45° field of view, color fundus photograph, image size 2352x1568: 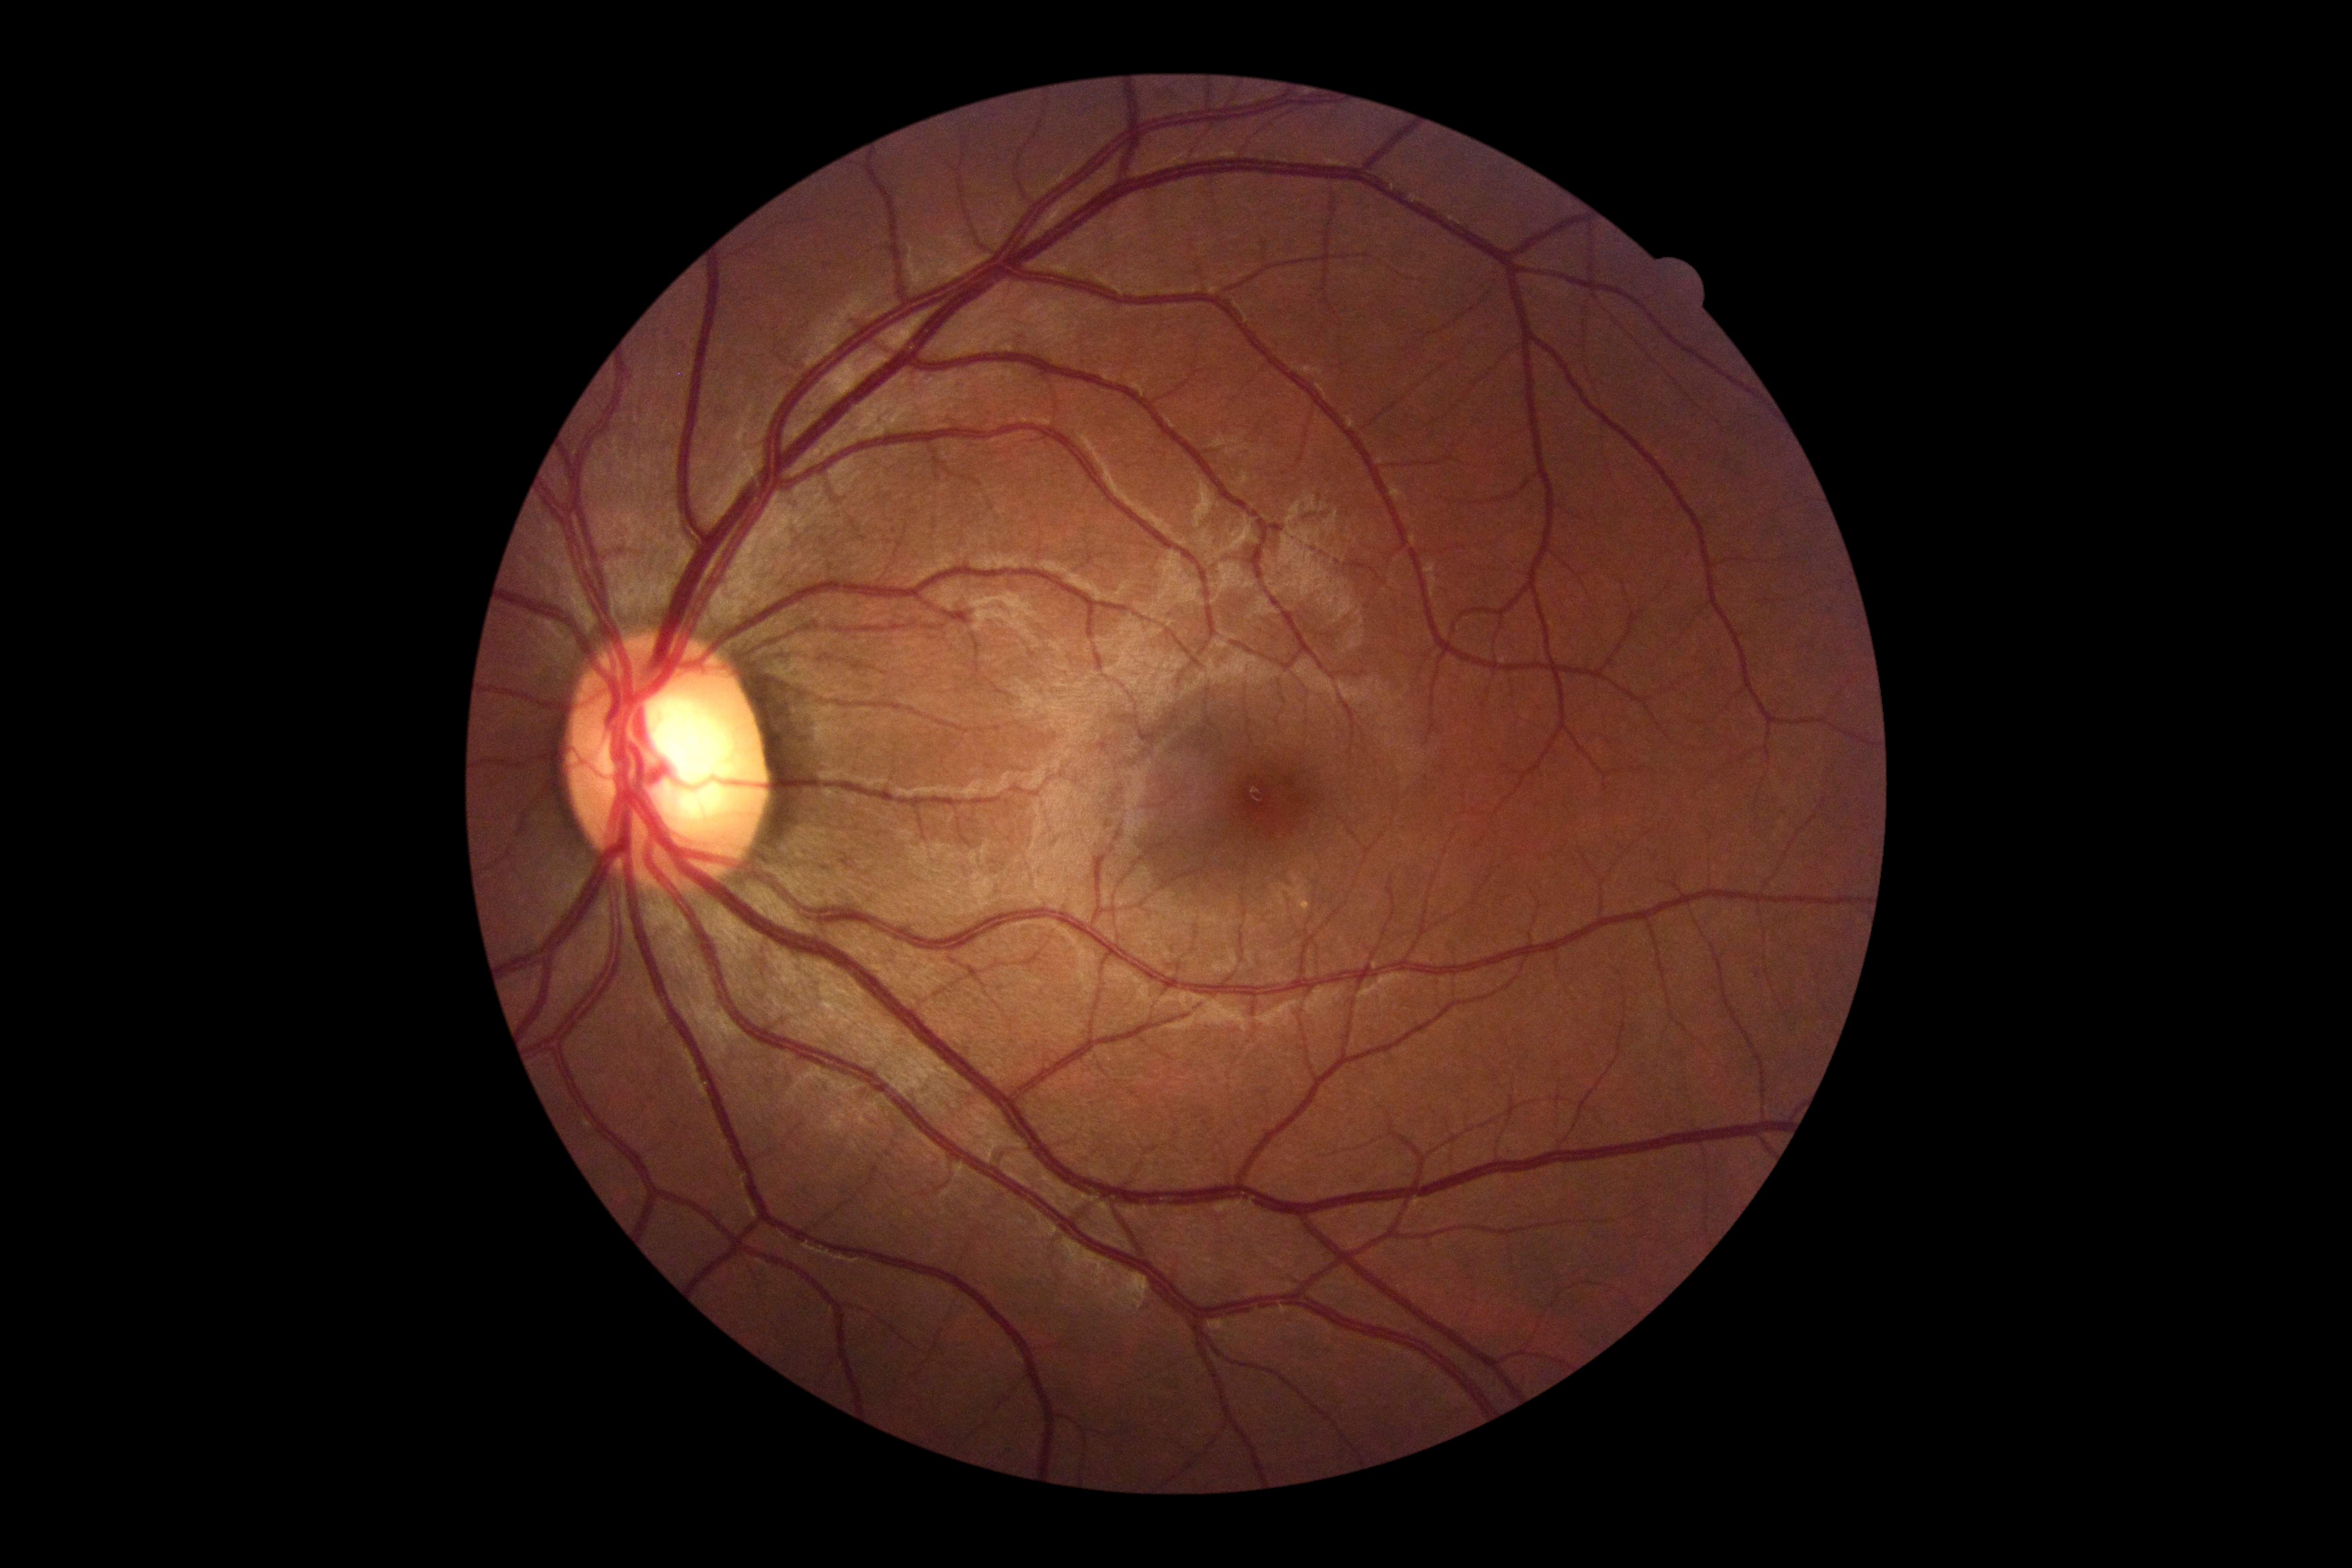 Diabetic retinopathy severity is no apparent diabetic retinopathy (grade 0).